45-degree field of view
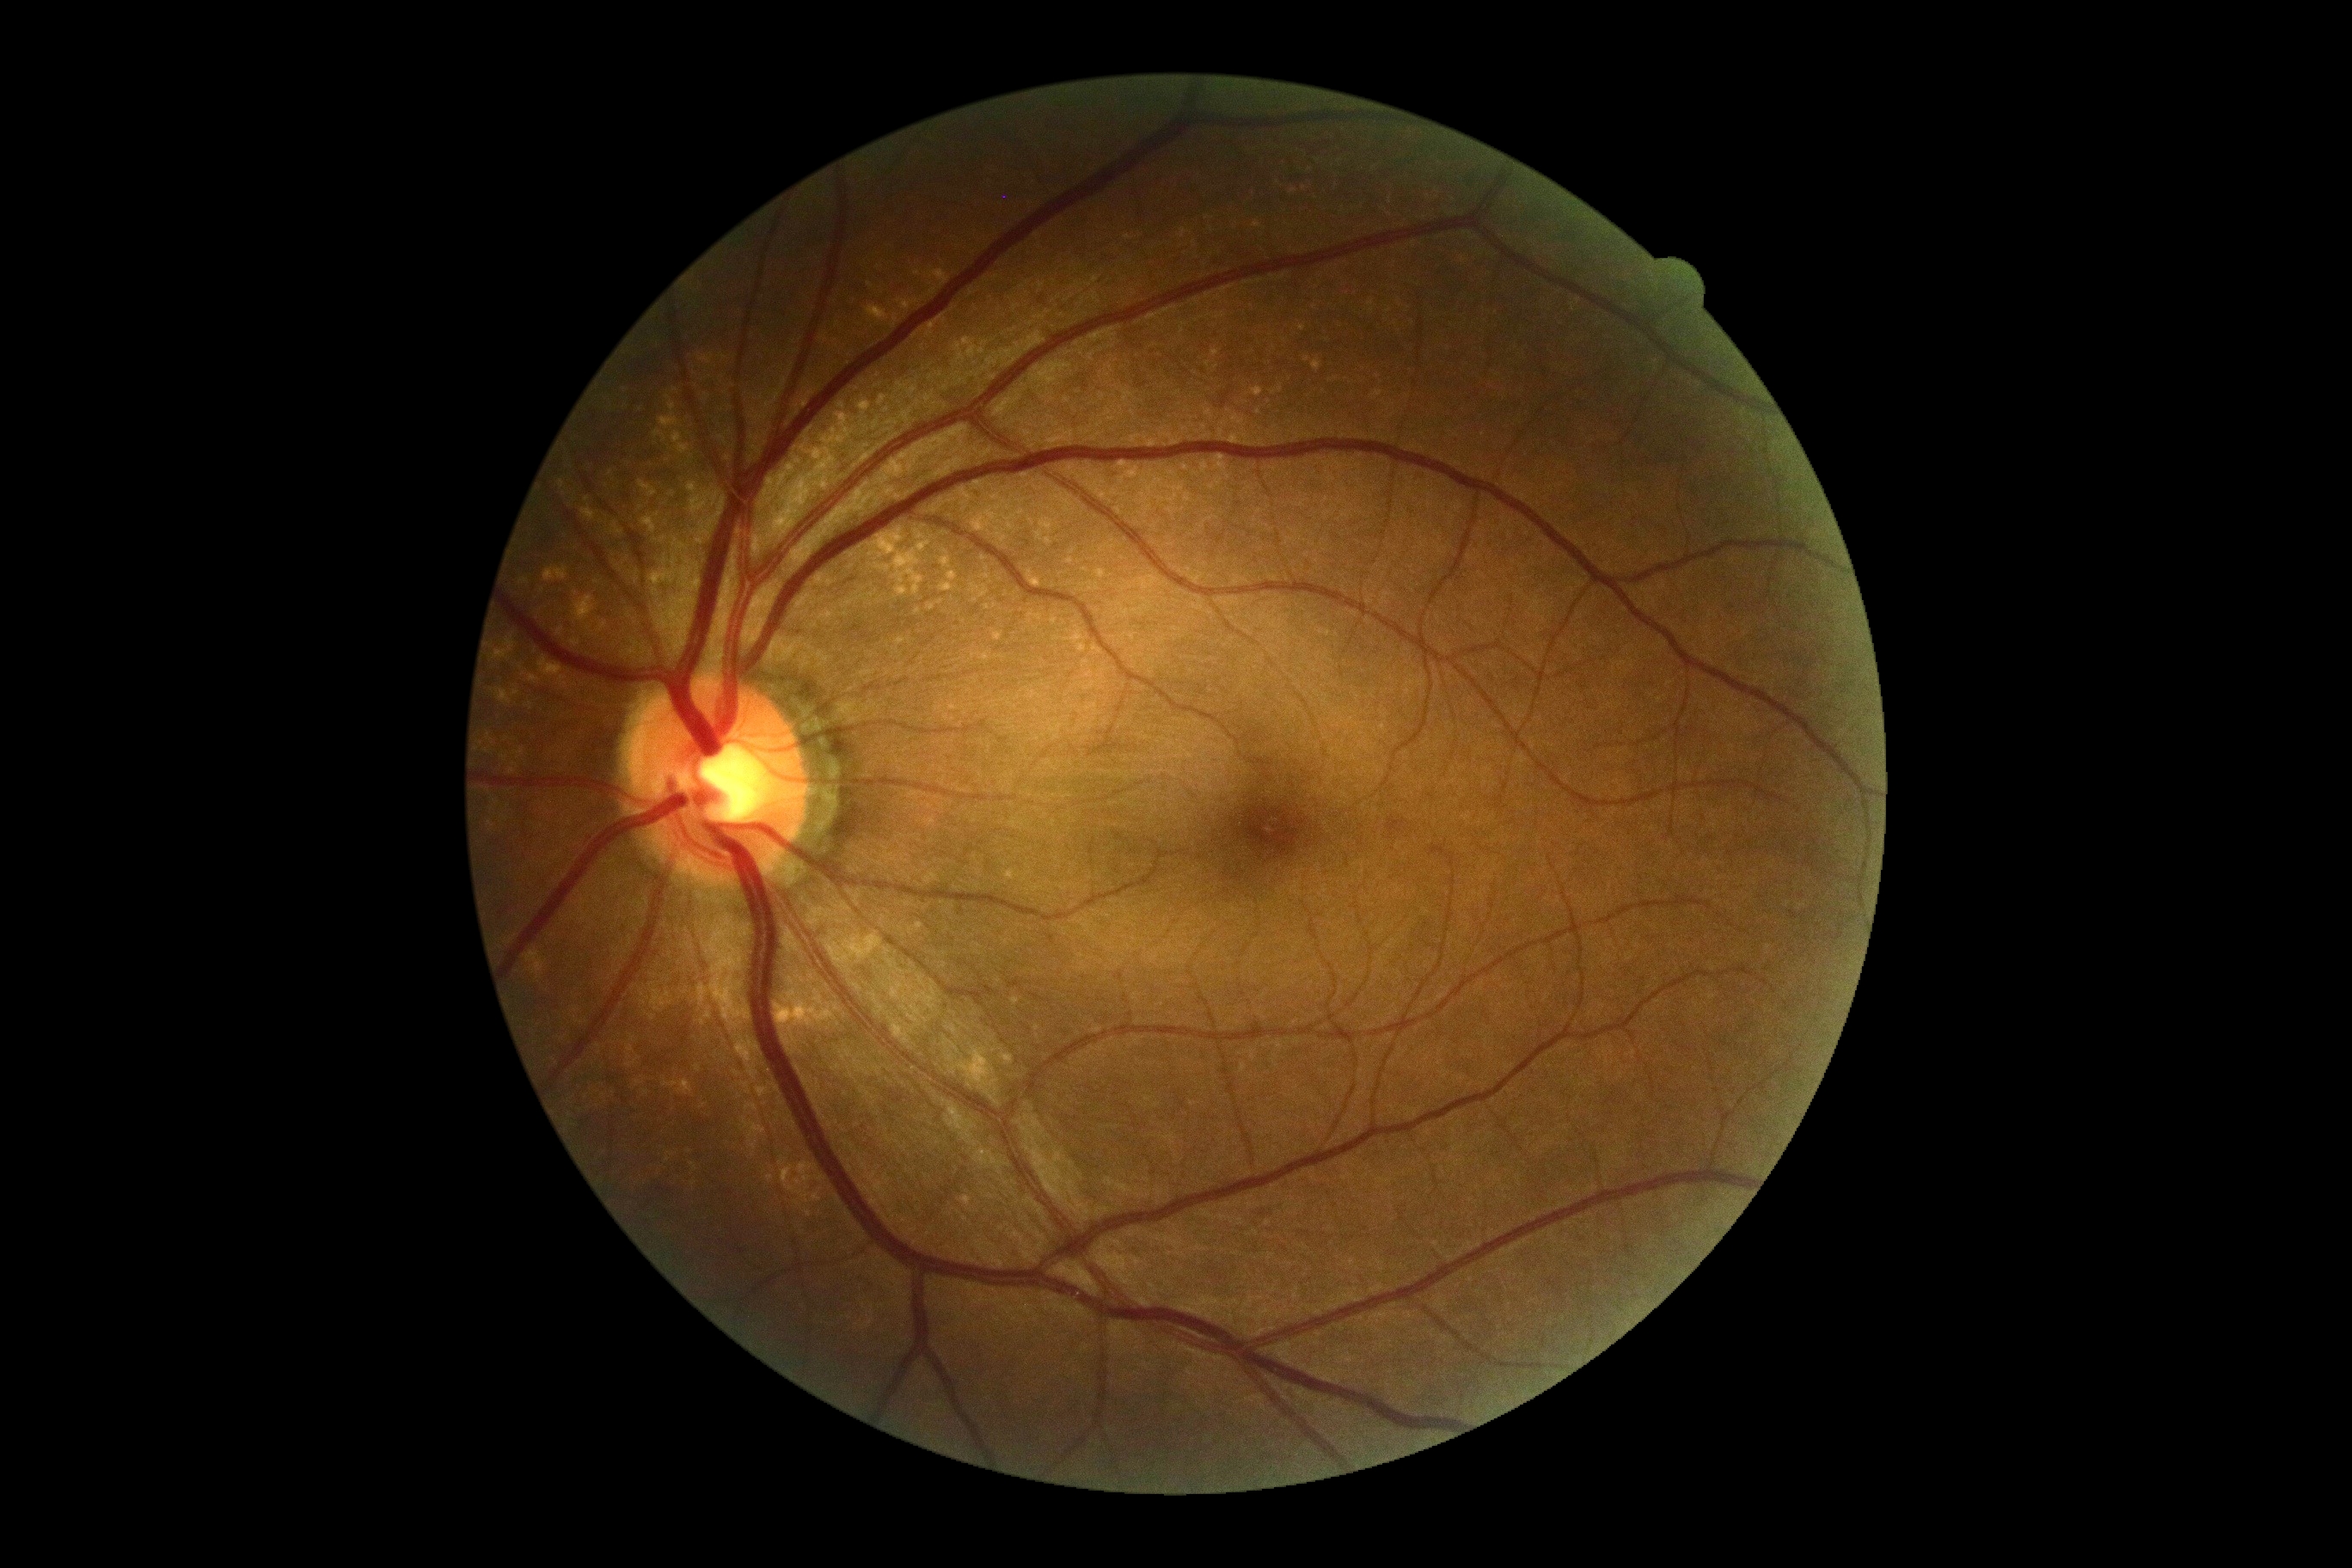

No signs of diabetic retinopathy. DR stage is 0.